Retinal fundus photograph: 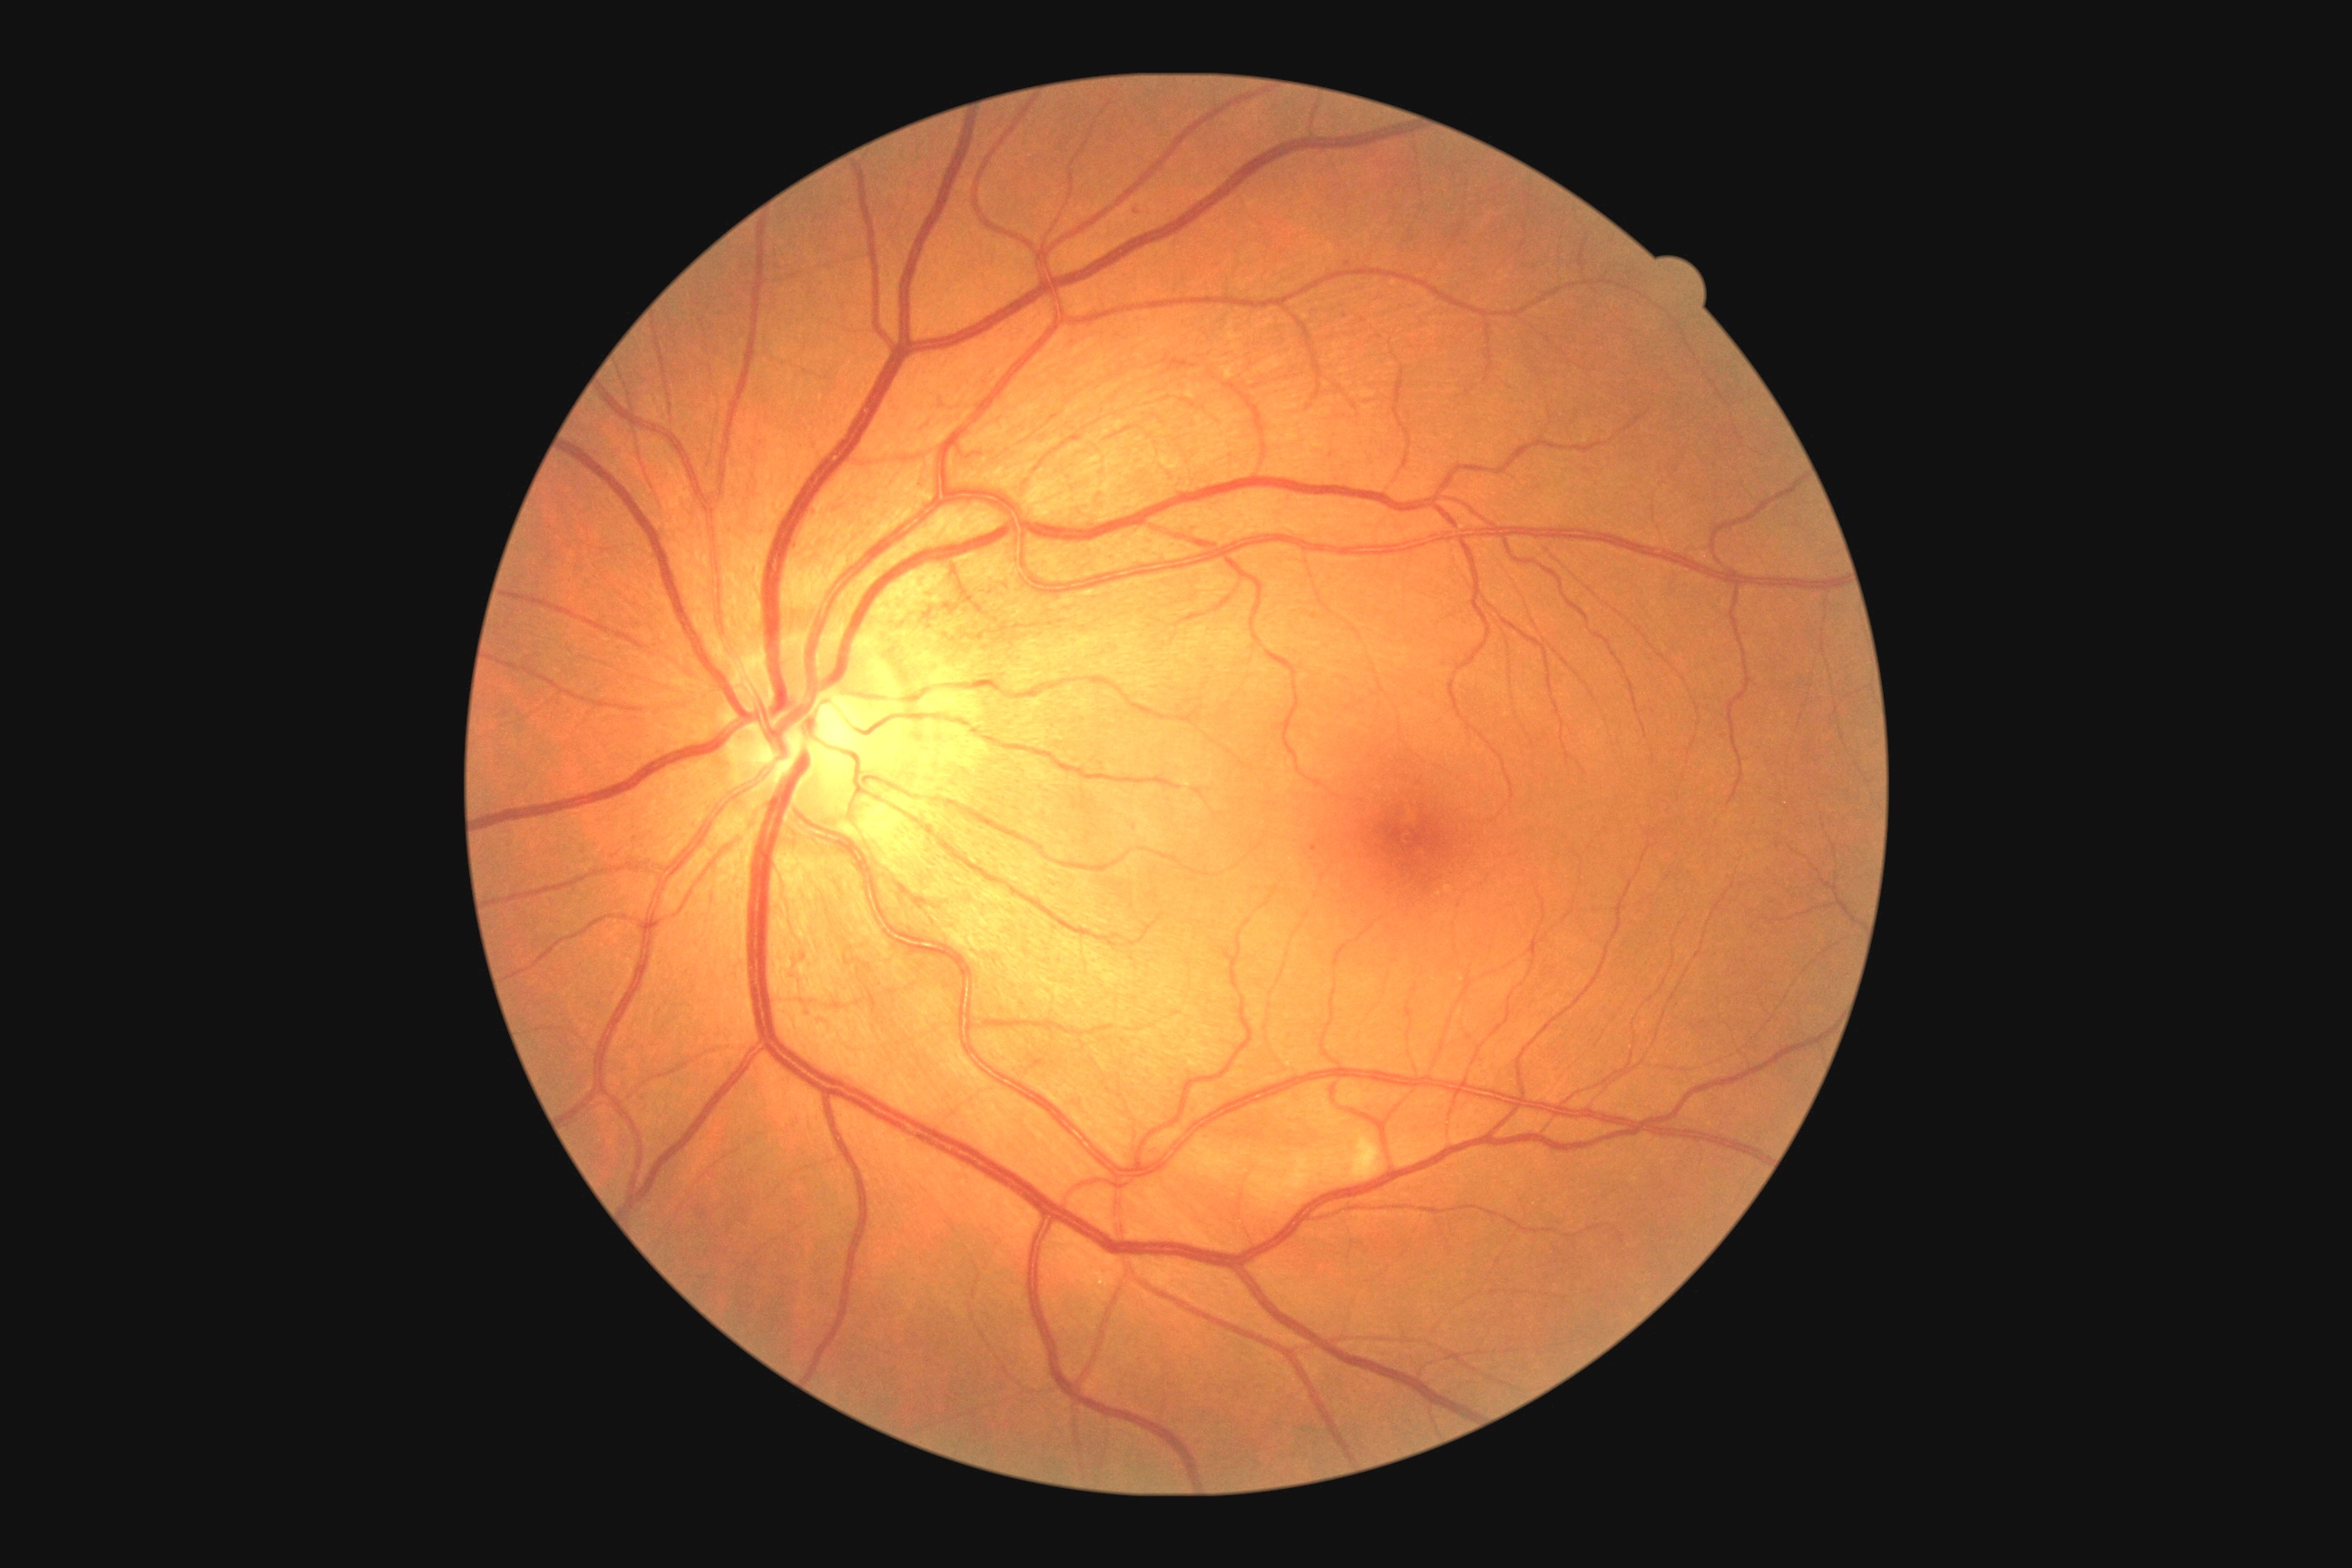
DR: moderate non-proliferative diabetic retinopathy (grade 2).